Modified Davis grading — 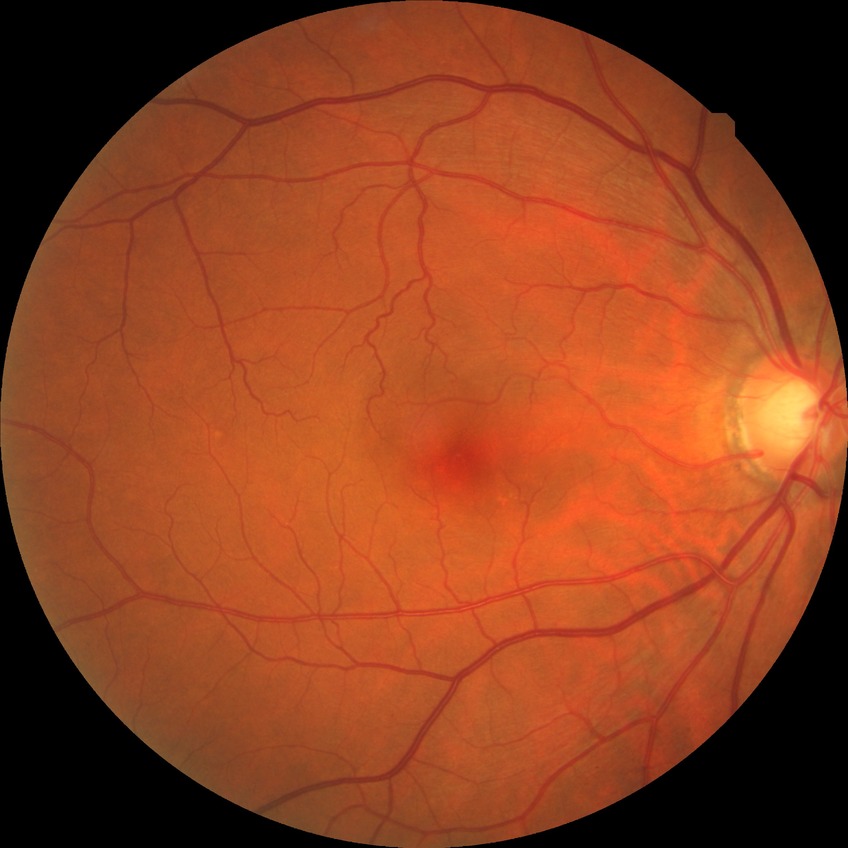
Annotations:
* diabetic retinopathy (DR) — no diabetic retinopathy (NDR)